FOV: 45 degrees; color fundus image; 848x848; without pupil dilation; NIDEK AFC-230 fundus camera.
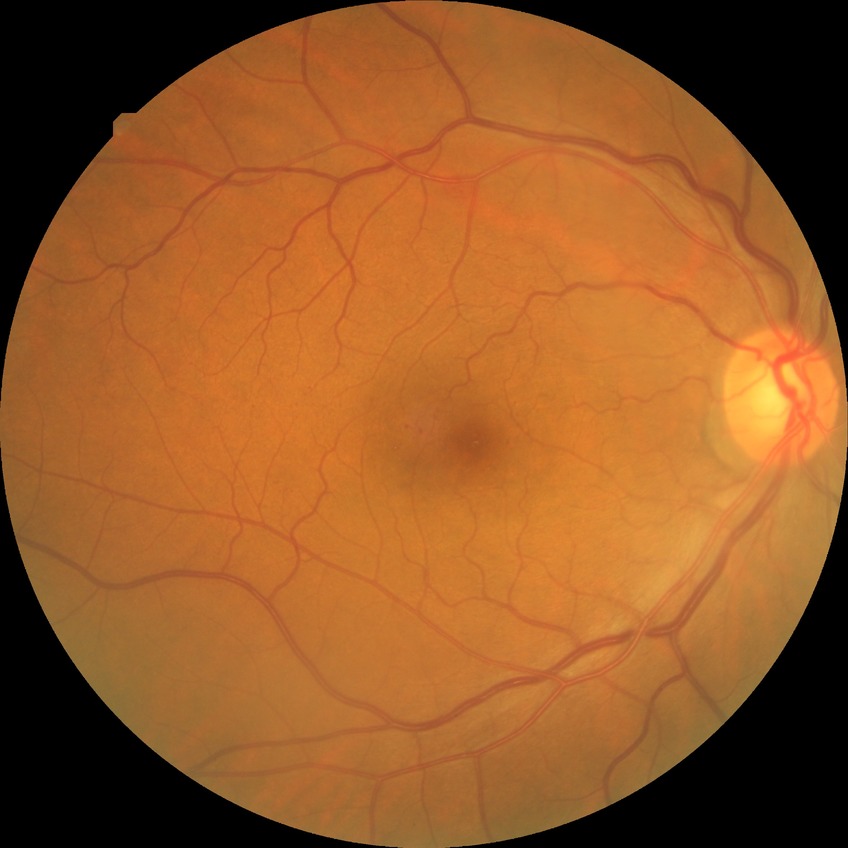
Diabetic retinopathy (DR) is simple diabetic retinopathy (SDR).